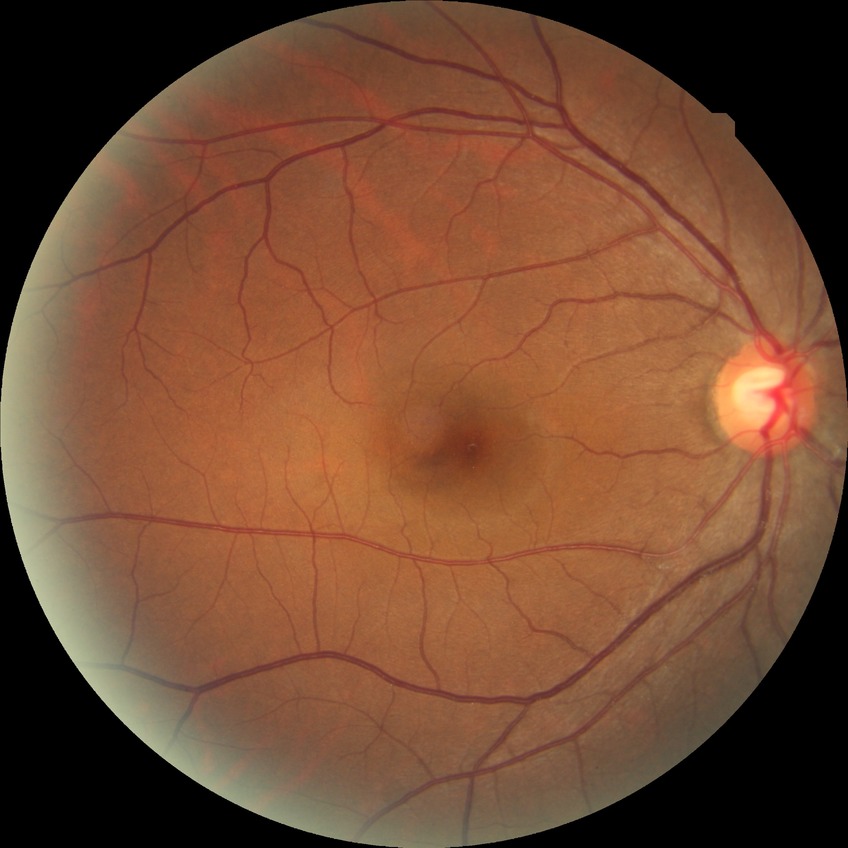
retinopathy grade: no diabetic retinopathy